848x848px. Nonmydriatic. Acquired with a NIDEK AFC-230. Posterior pole color fundus photograph.
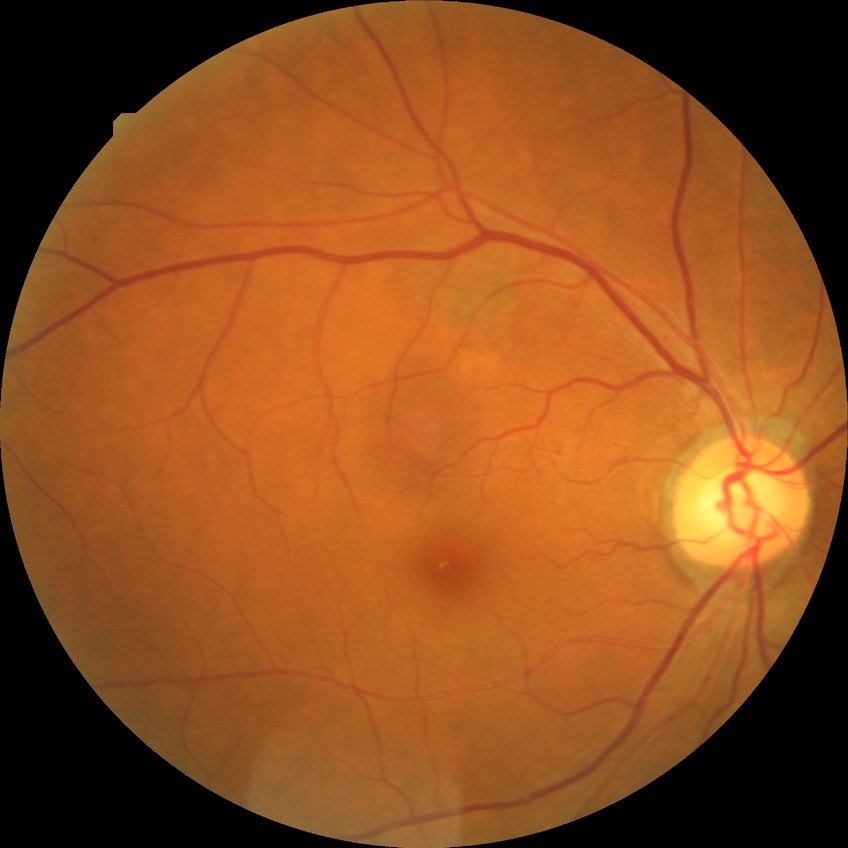

Diabetic retinopathy (DR) is simple diabetic retinopathy (SDR).